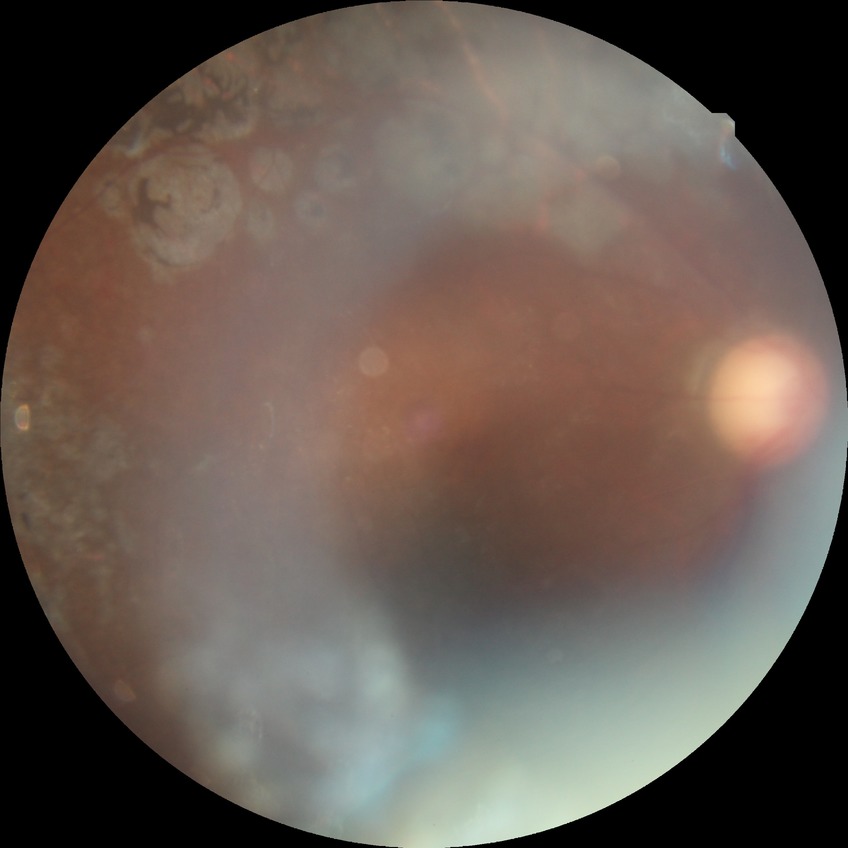 diabetic retinopathy (DR)=PDR (proliferative diabetic retinopathy).